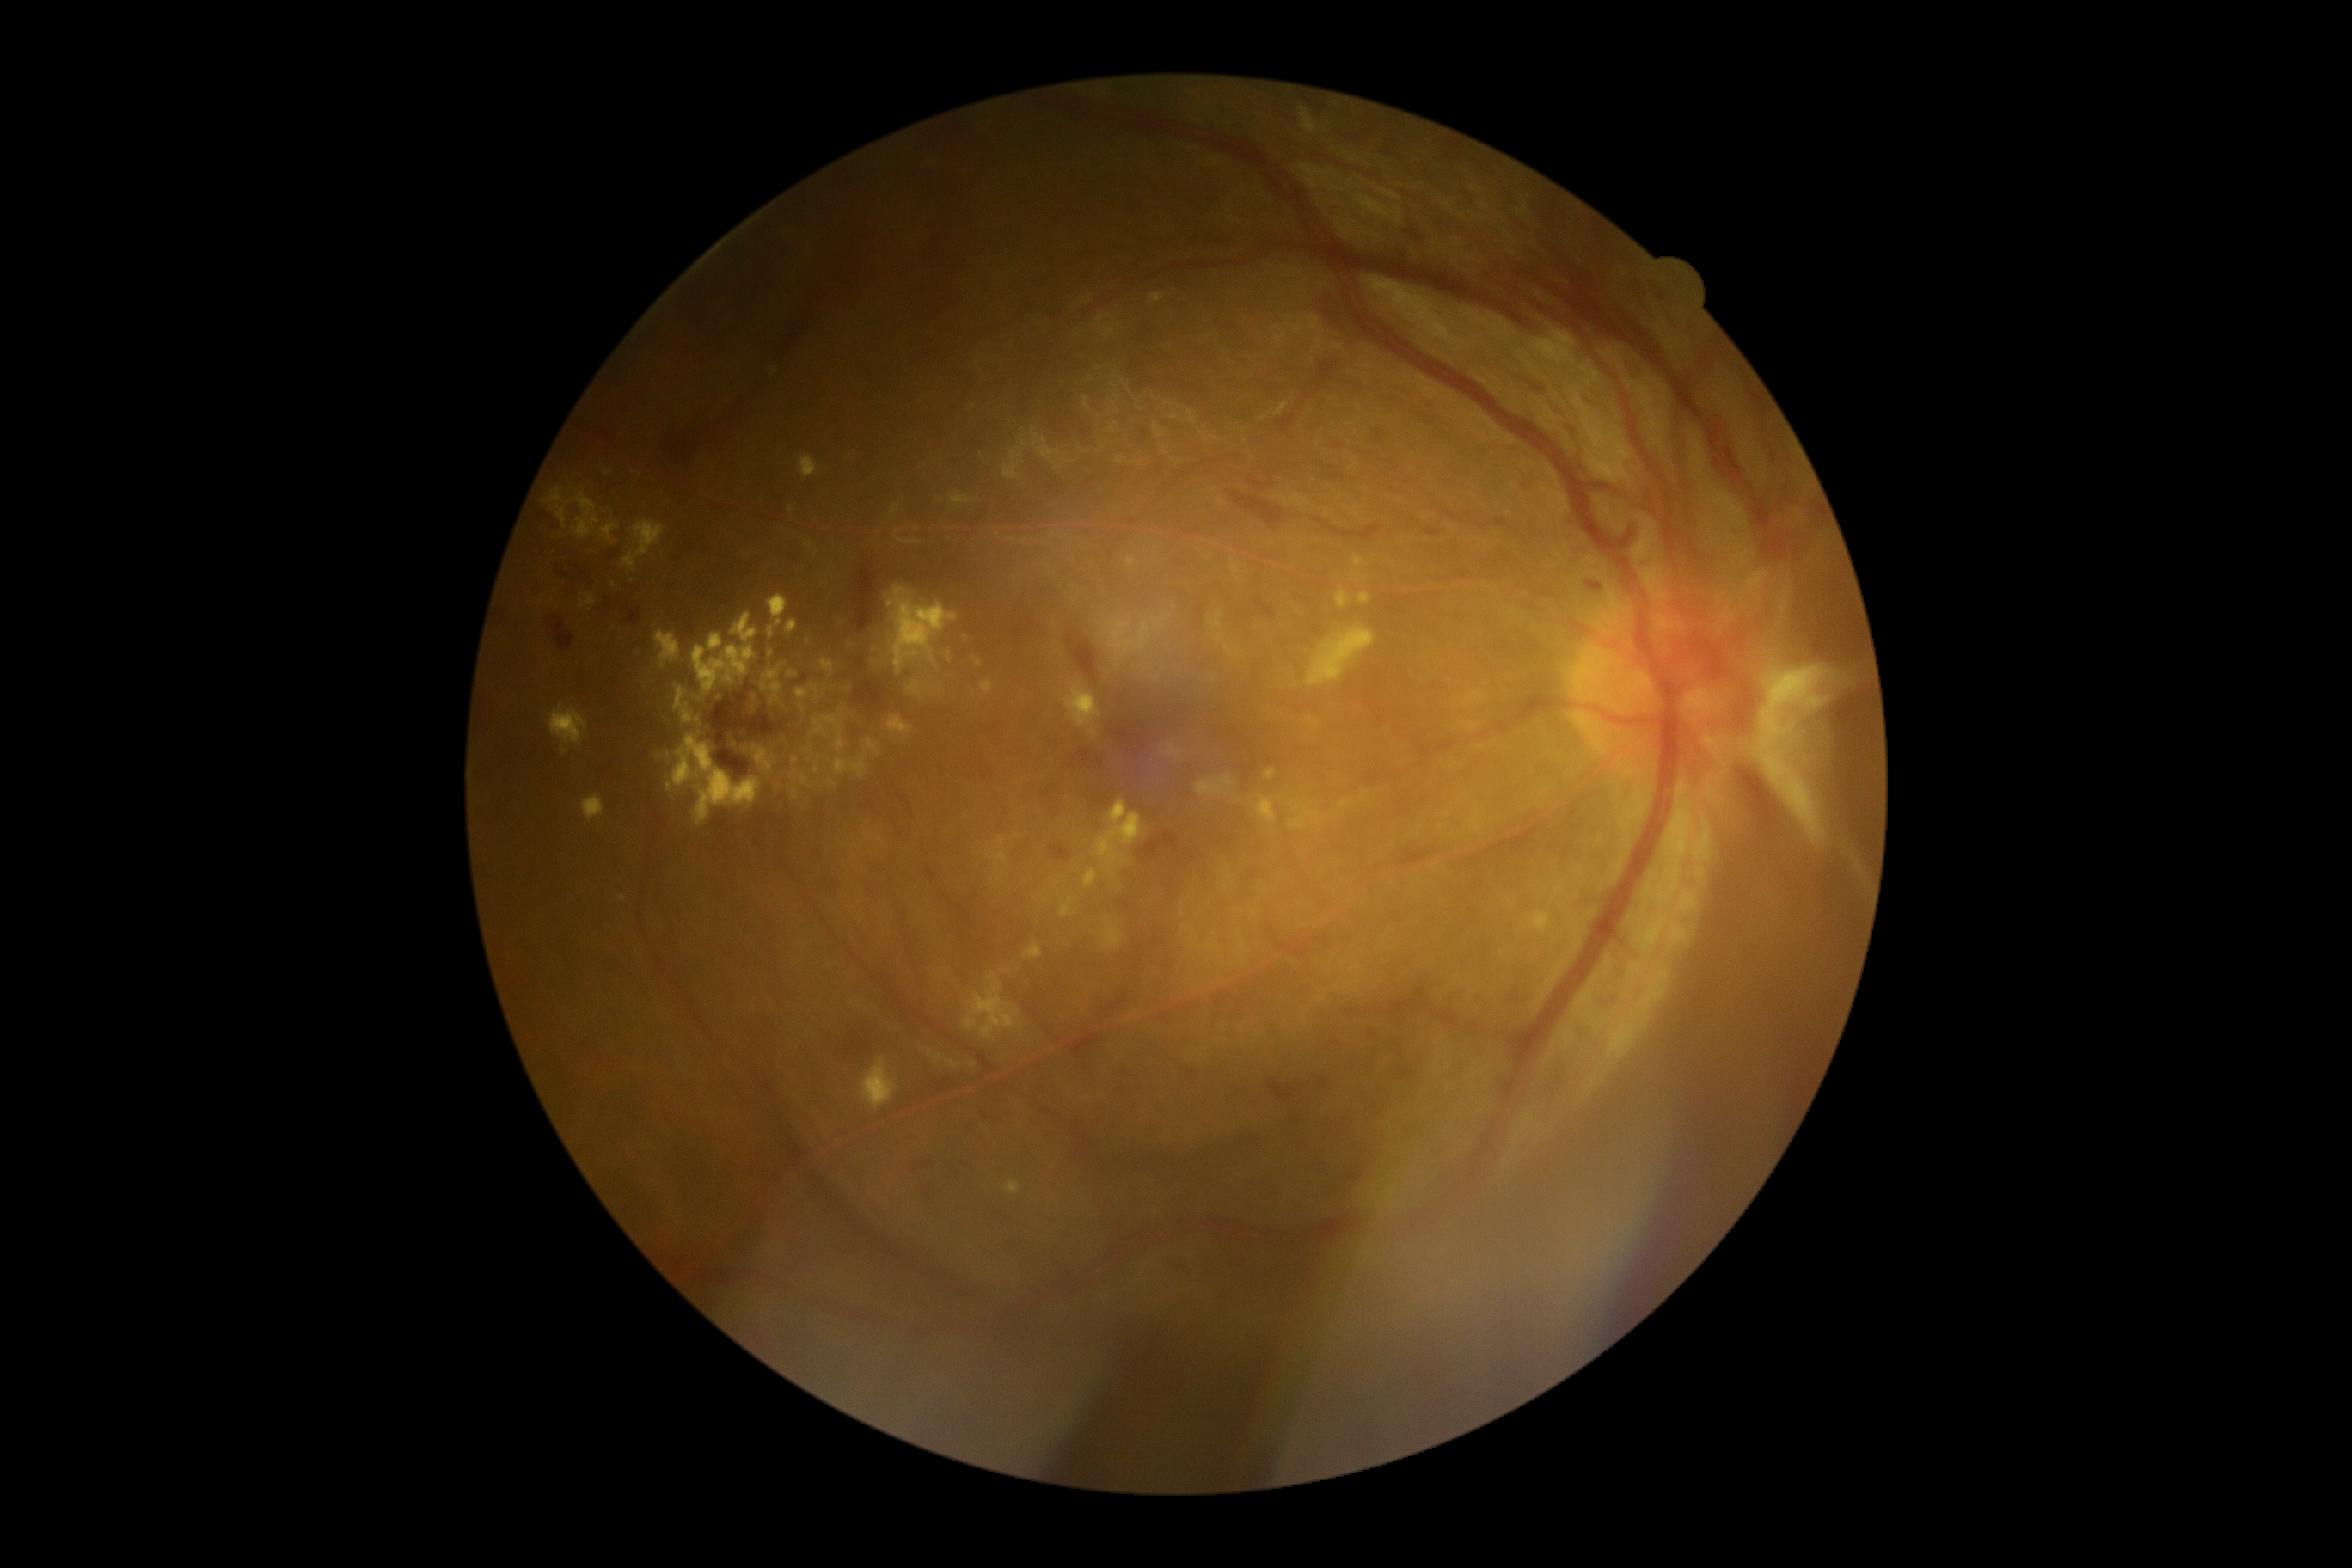 Diabetic retinopathy severity is 4 — neovascularization and/or vitreous/pre-retinal hemorrhage
Representative lesions:
hemorrhages (more not shown): 1251:479:1259:487 | 1146:1129:1158:1137 | 1251:1096:1261:1108 | 622:604:642:627 | 981:1117:1001:1124 | 1414:984:1428:998 | 926:1187:934:1203 | 1739:768:1782:835 | 1254:597:1275:618 | 1041:785:1057:802 | 792:673:809:685 | 1342:1167:1363:1182 | 843:1032:871:1058 | 548:618:573:658 | 1069:632:1098:683
Hemorrhages (small, approximate centers) near (1373,1034) | (1125,1071)
hard exudates (more not shown): 1308:627:1375:687 | 1127:556:1136:568 | 1060:897:1075:917 | 768:596:788:627 | 1113:799:1125:818 | 928:1050:965:1070 | 1258:797:1278:823 | 549:706:589:747 | 972:656:983:668 | 768:659:787:680 | 828:780:836:788 | 757:749:768:764 | 1084:869:1098:888
Hard exudates (small, approximate centers) near (769,767) | (963,637) | (668,786) | (850,645) | (816,552)